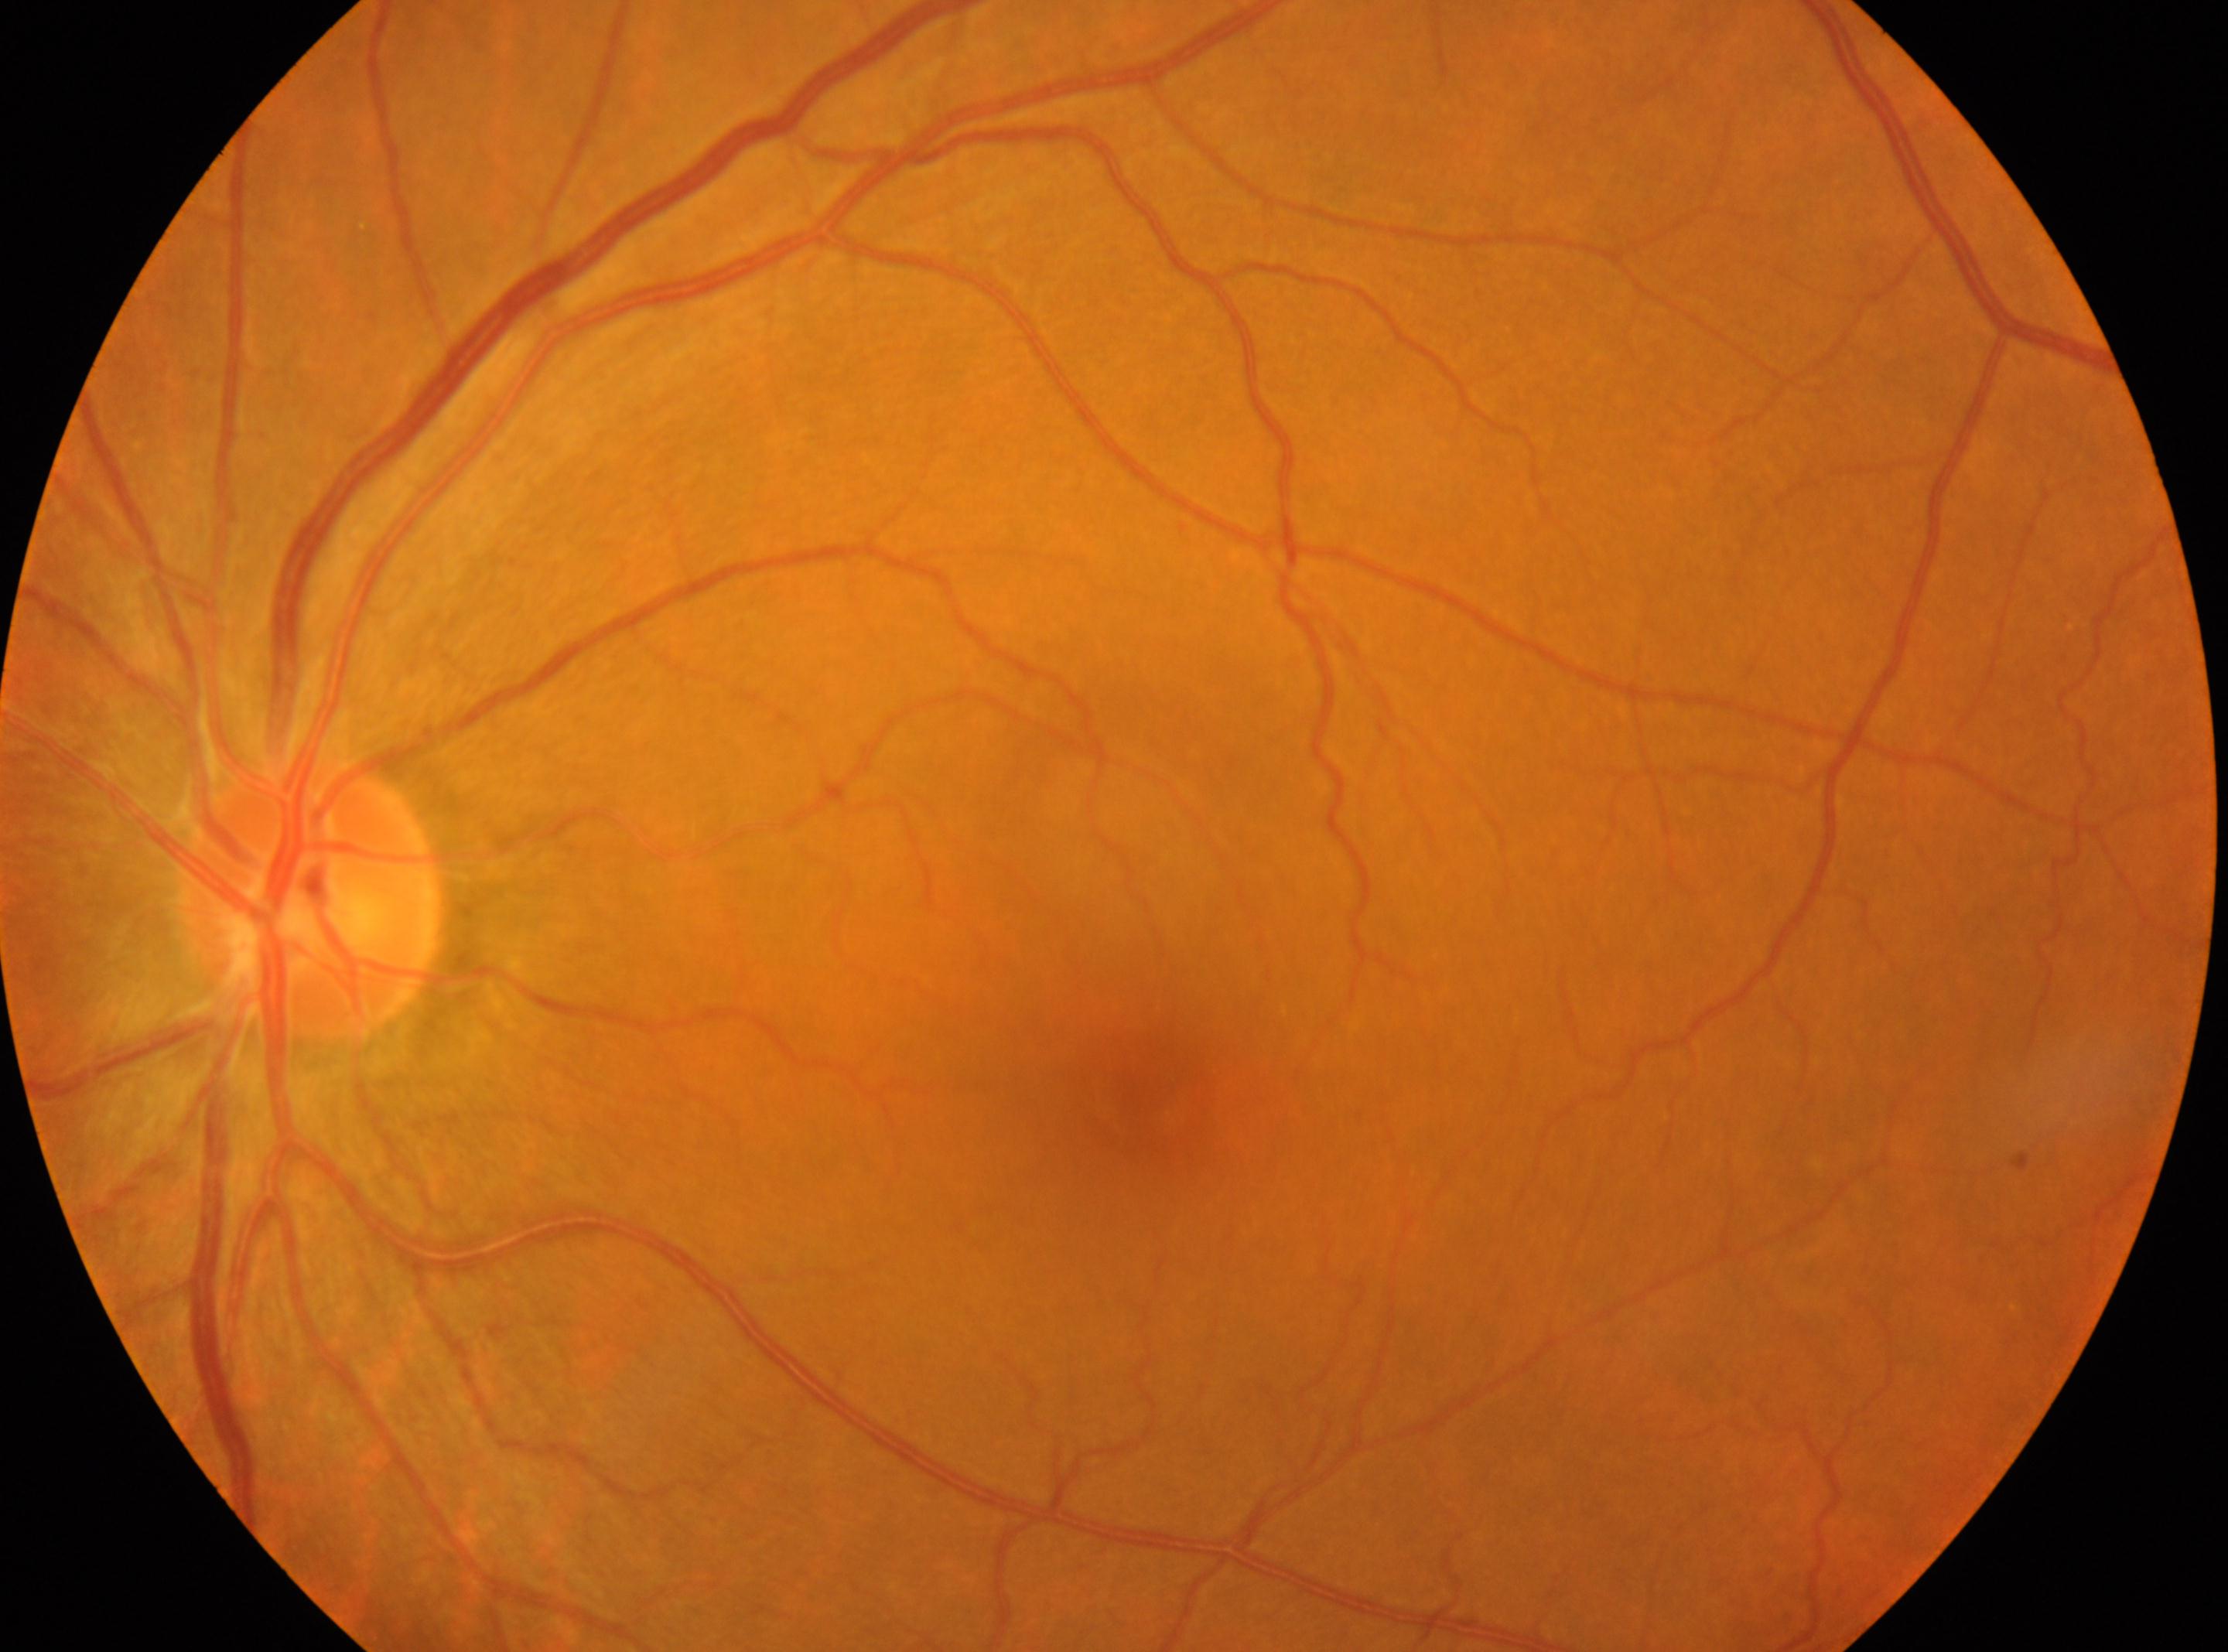 diabetic retinopathy grade: 0 | optic disc: 309, 899 | left | fovea: 1137, 1097.